FOV: 45 degrees:
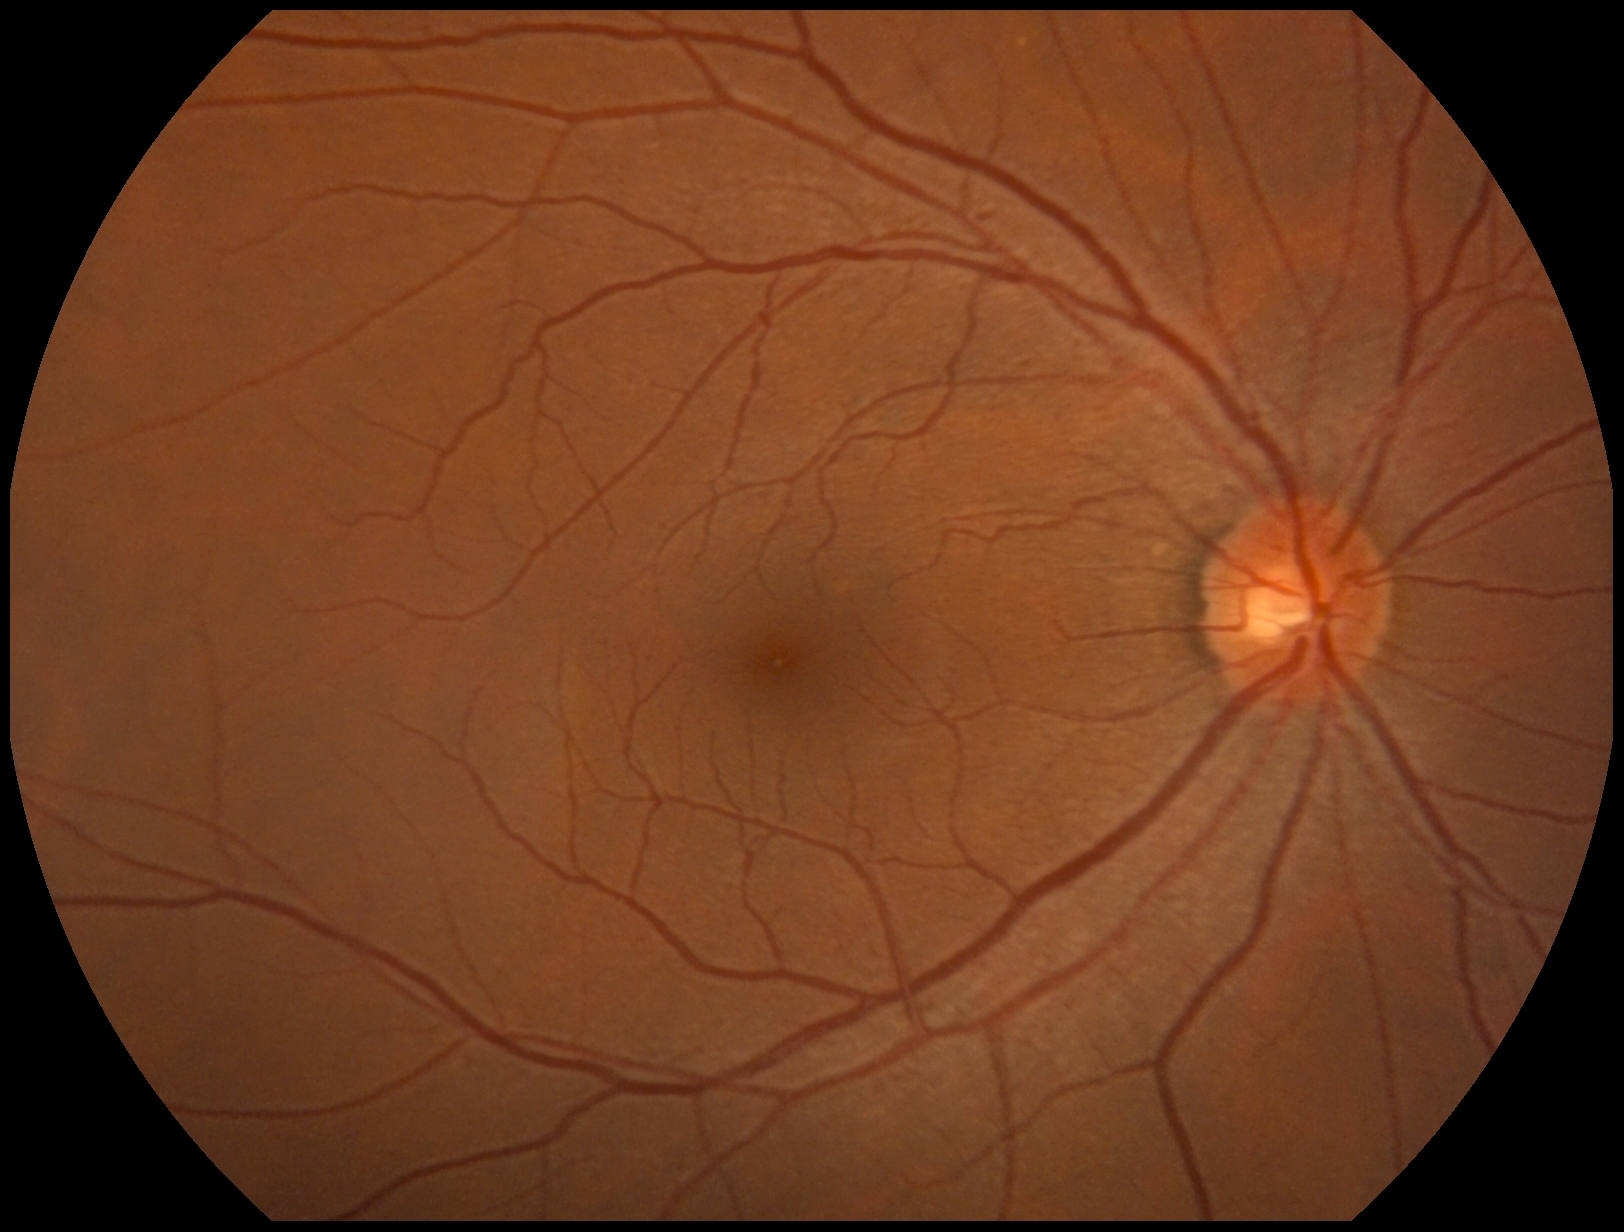
DR: grade 2 (moderate NPDR).